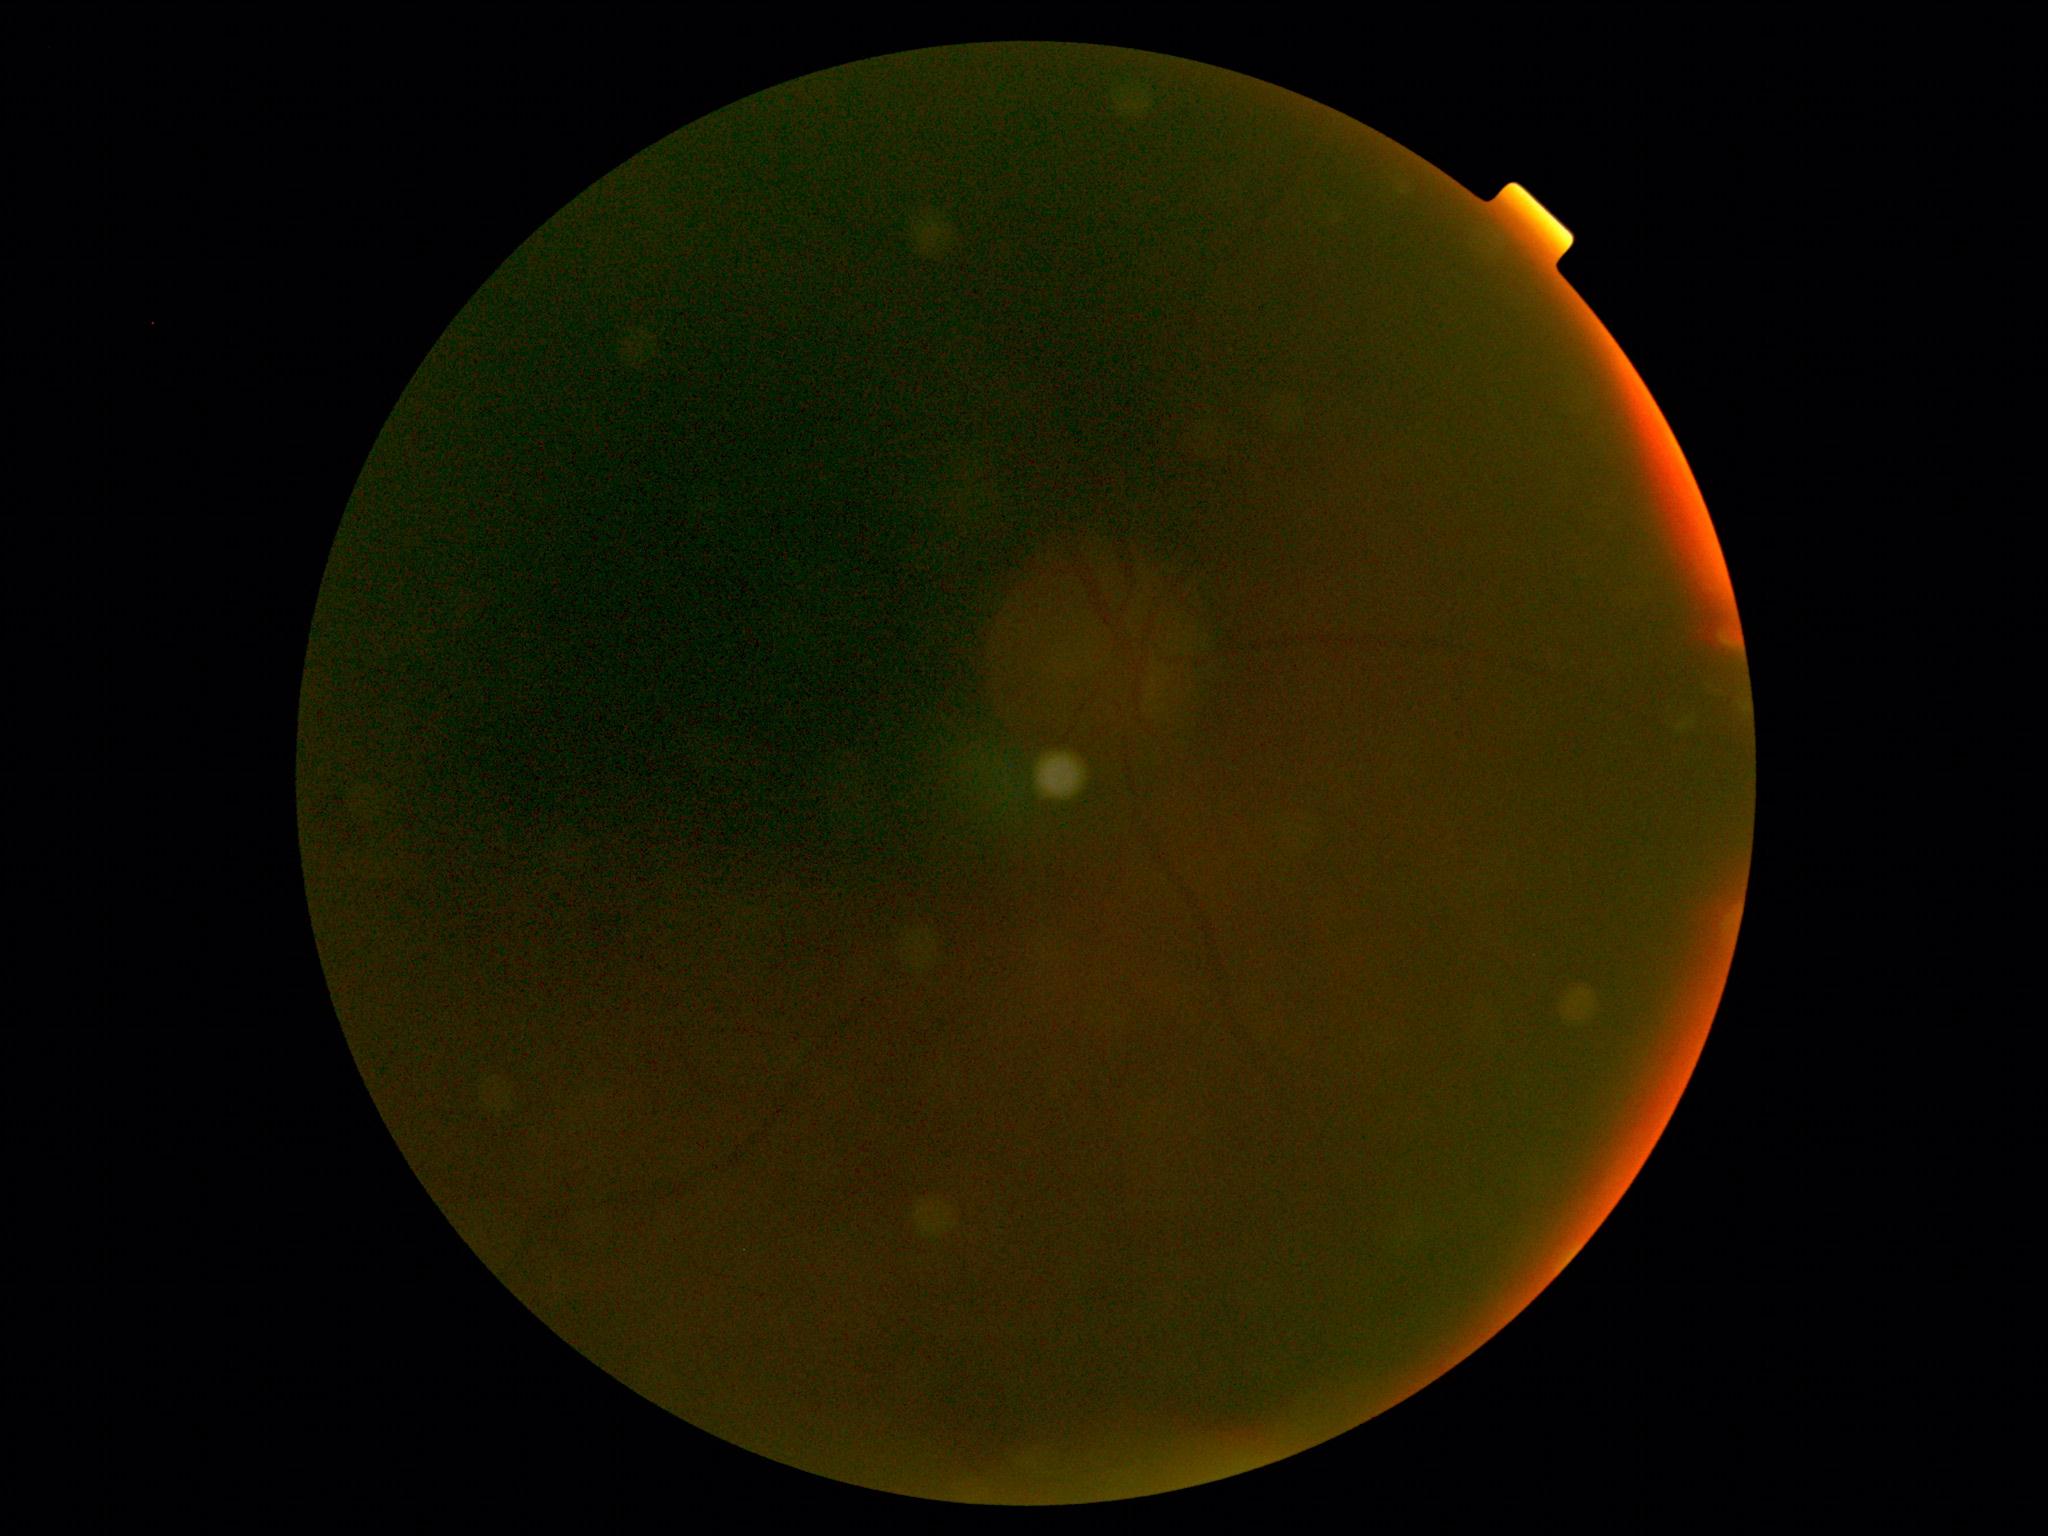

DR grade is ungradable due to poor image quality.
The image cannot be graded for diabetic retinopathy.